Optic disc-centered crop · acquired with a Nidek AFC-330 — 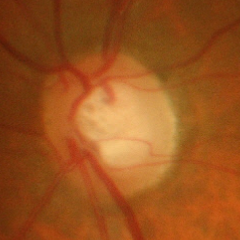
Q: What stage of glaucoma is present?
A: Yes — advanced glaucoma.